DR severity per modified Davis staging — 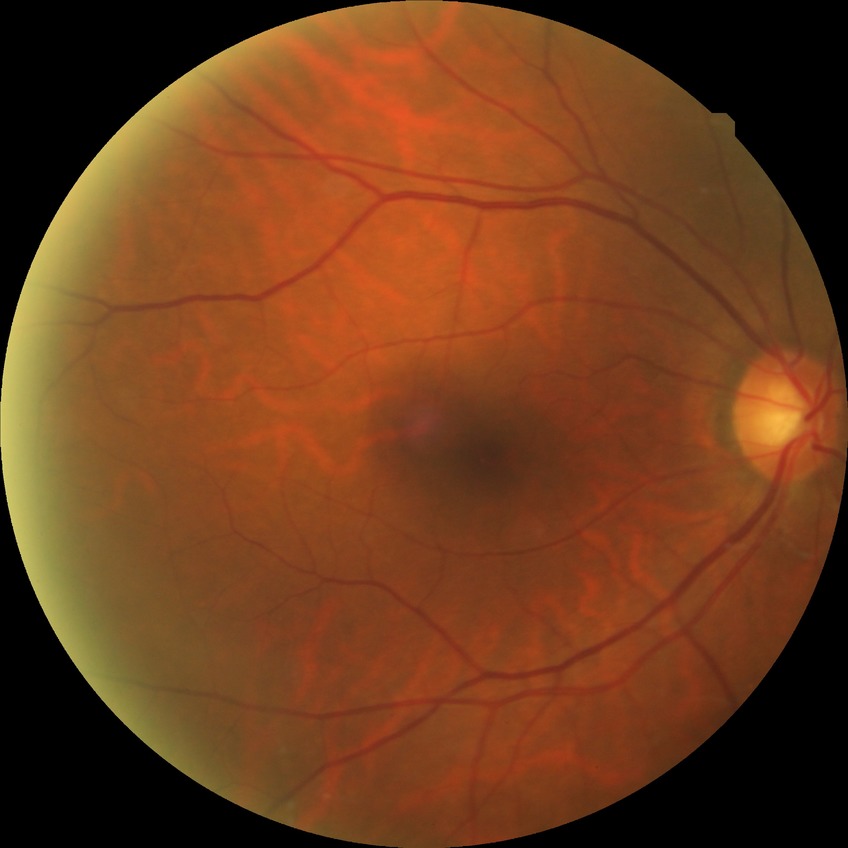

Retinopathy stage: no diabetic retinopathy.